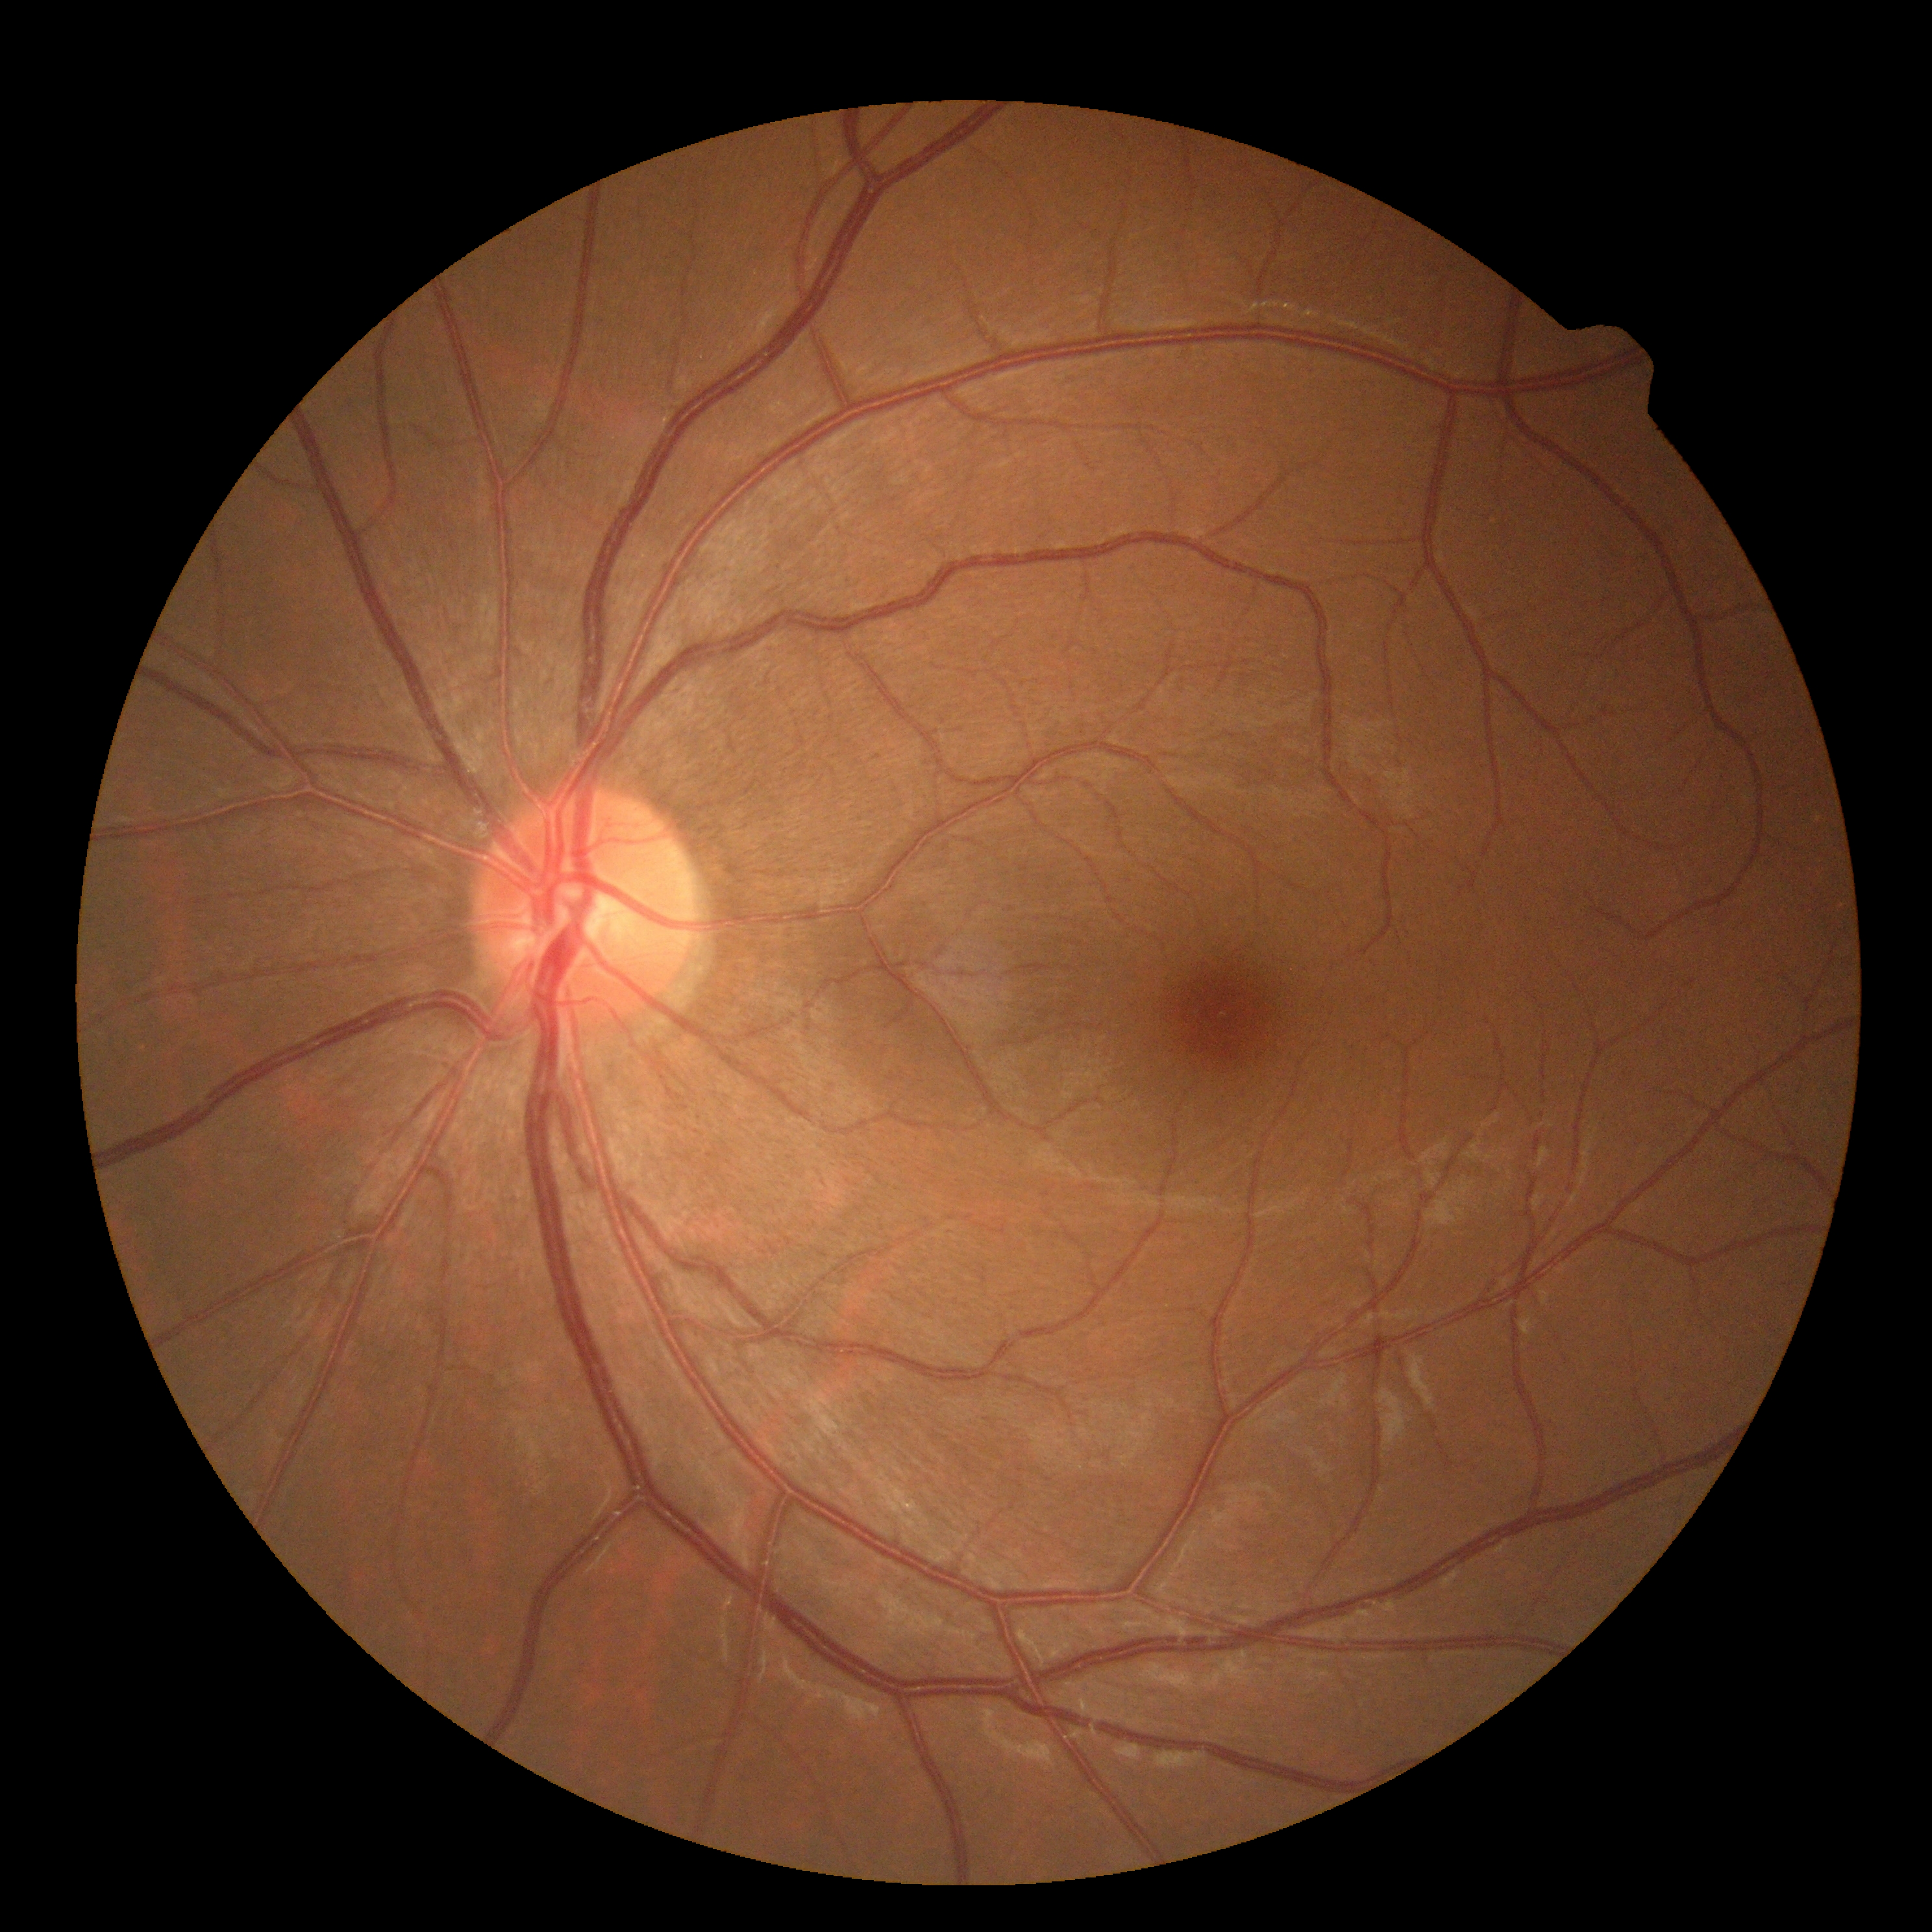

• DR — no apparent retinopathy (grade 0)